Wide-field contact fundus photograph of an infant — 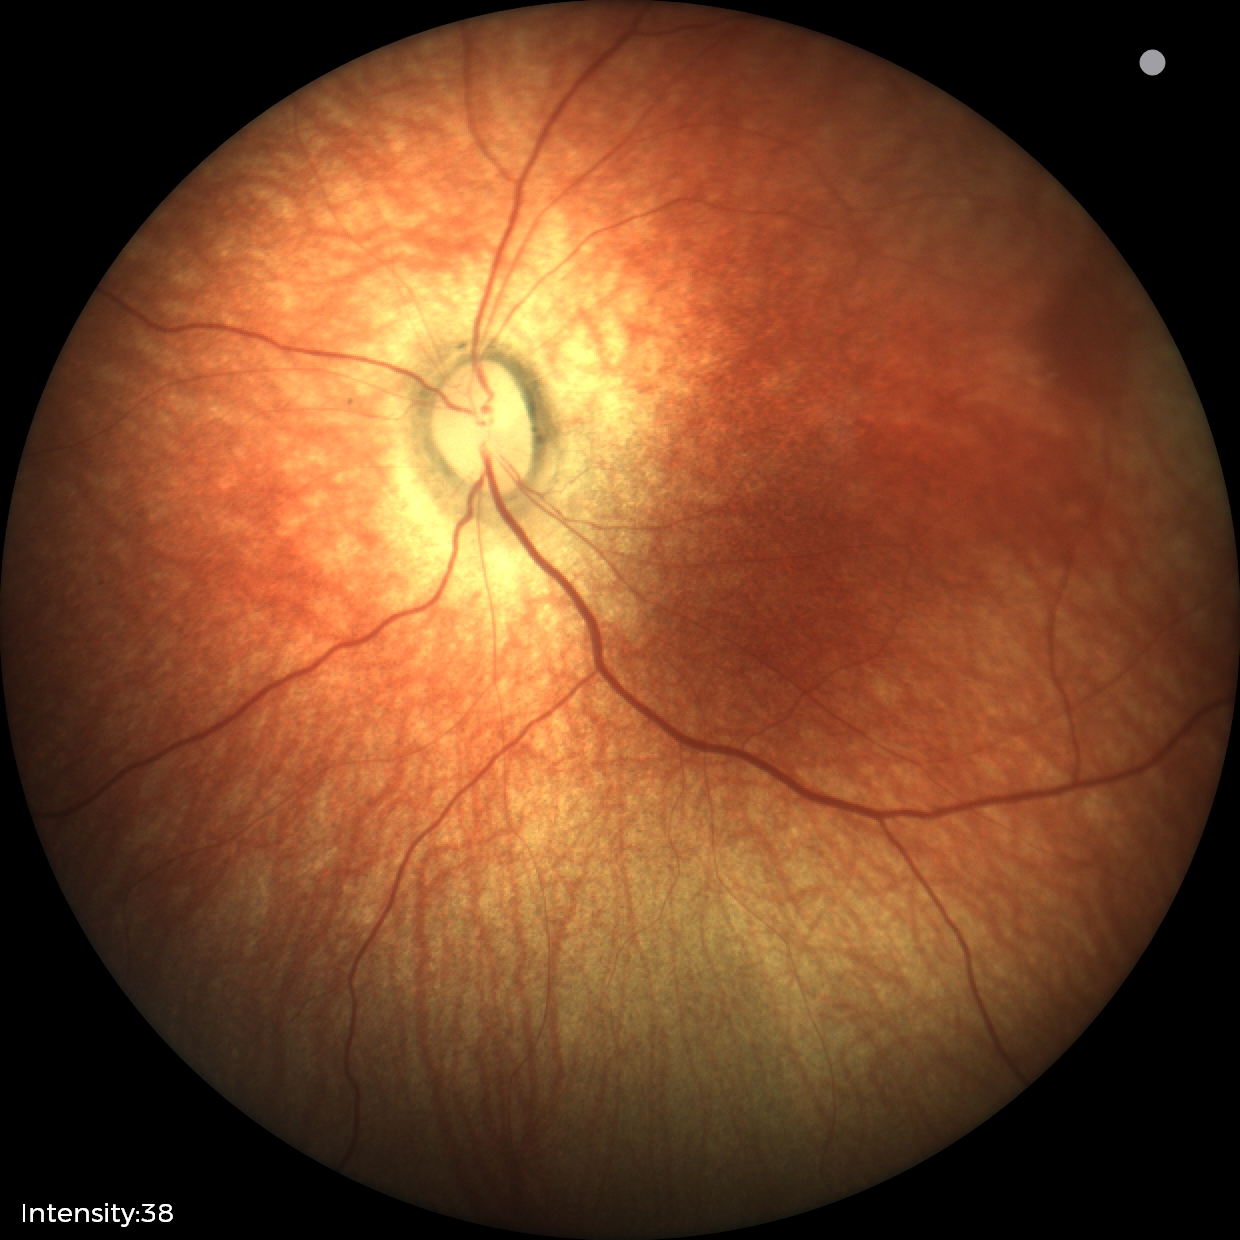
Q: What is the diagnosis from this examination?
A: physiological finding